Infant wide-field fundus photograph
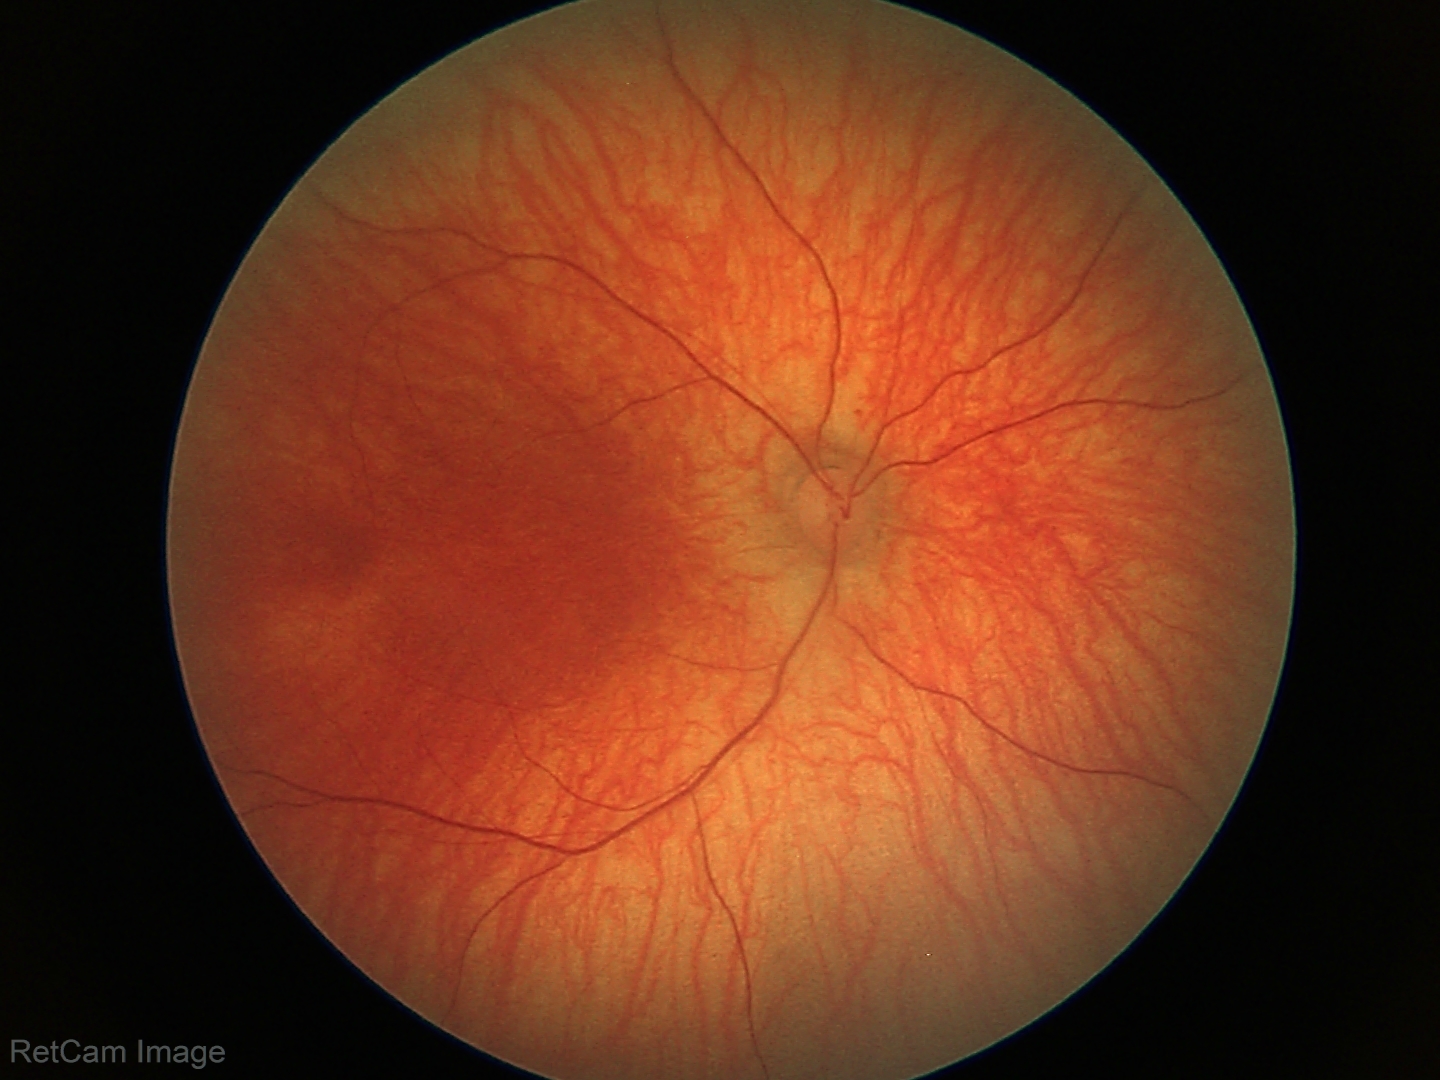 No retinal pathology identified on screening.